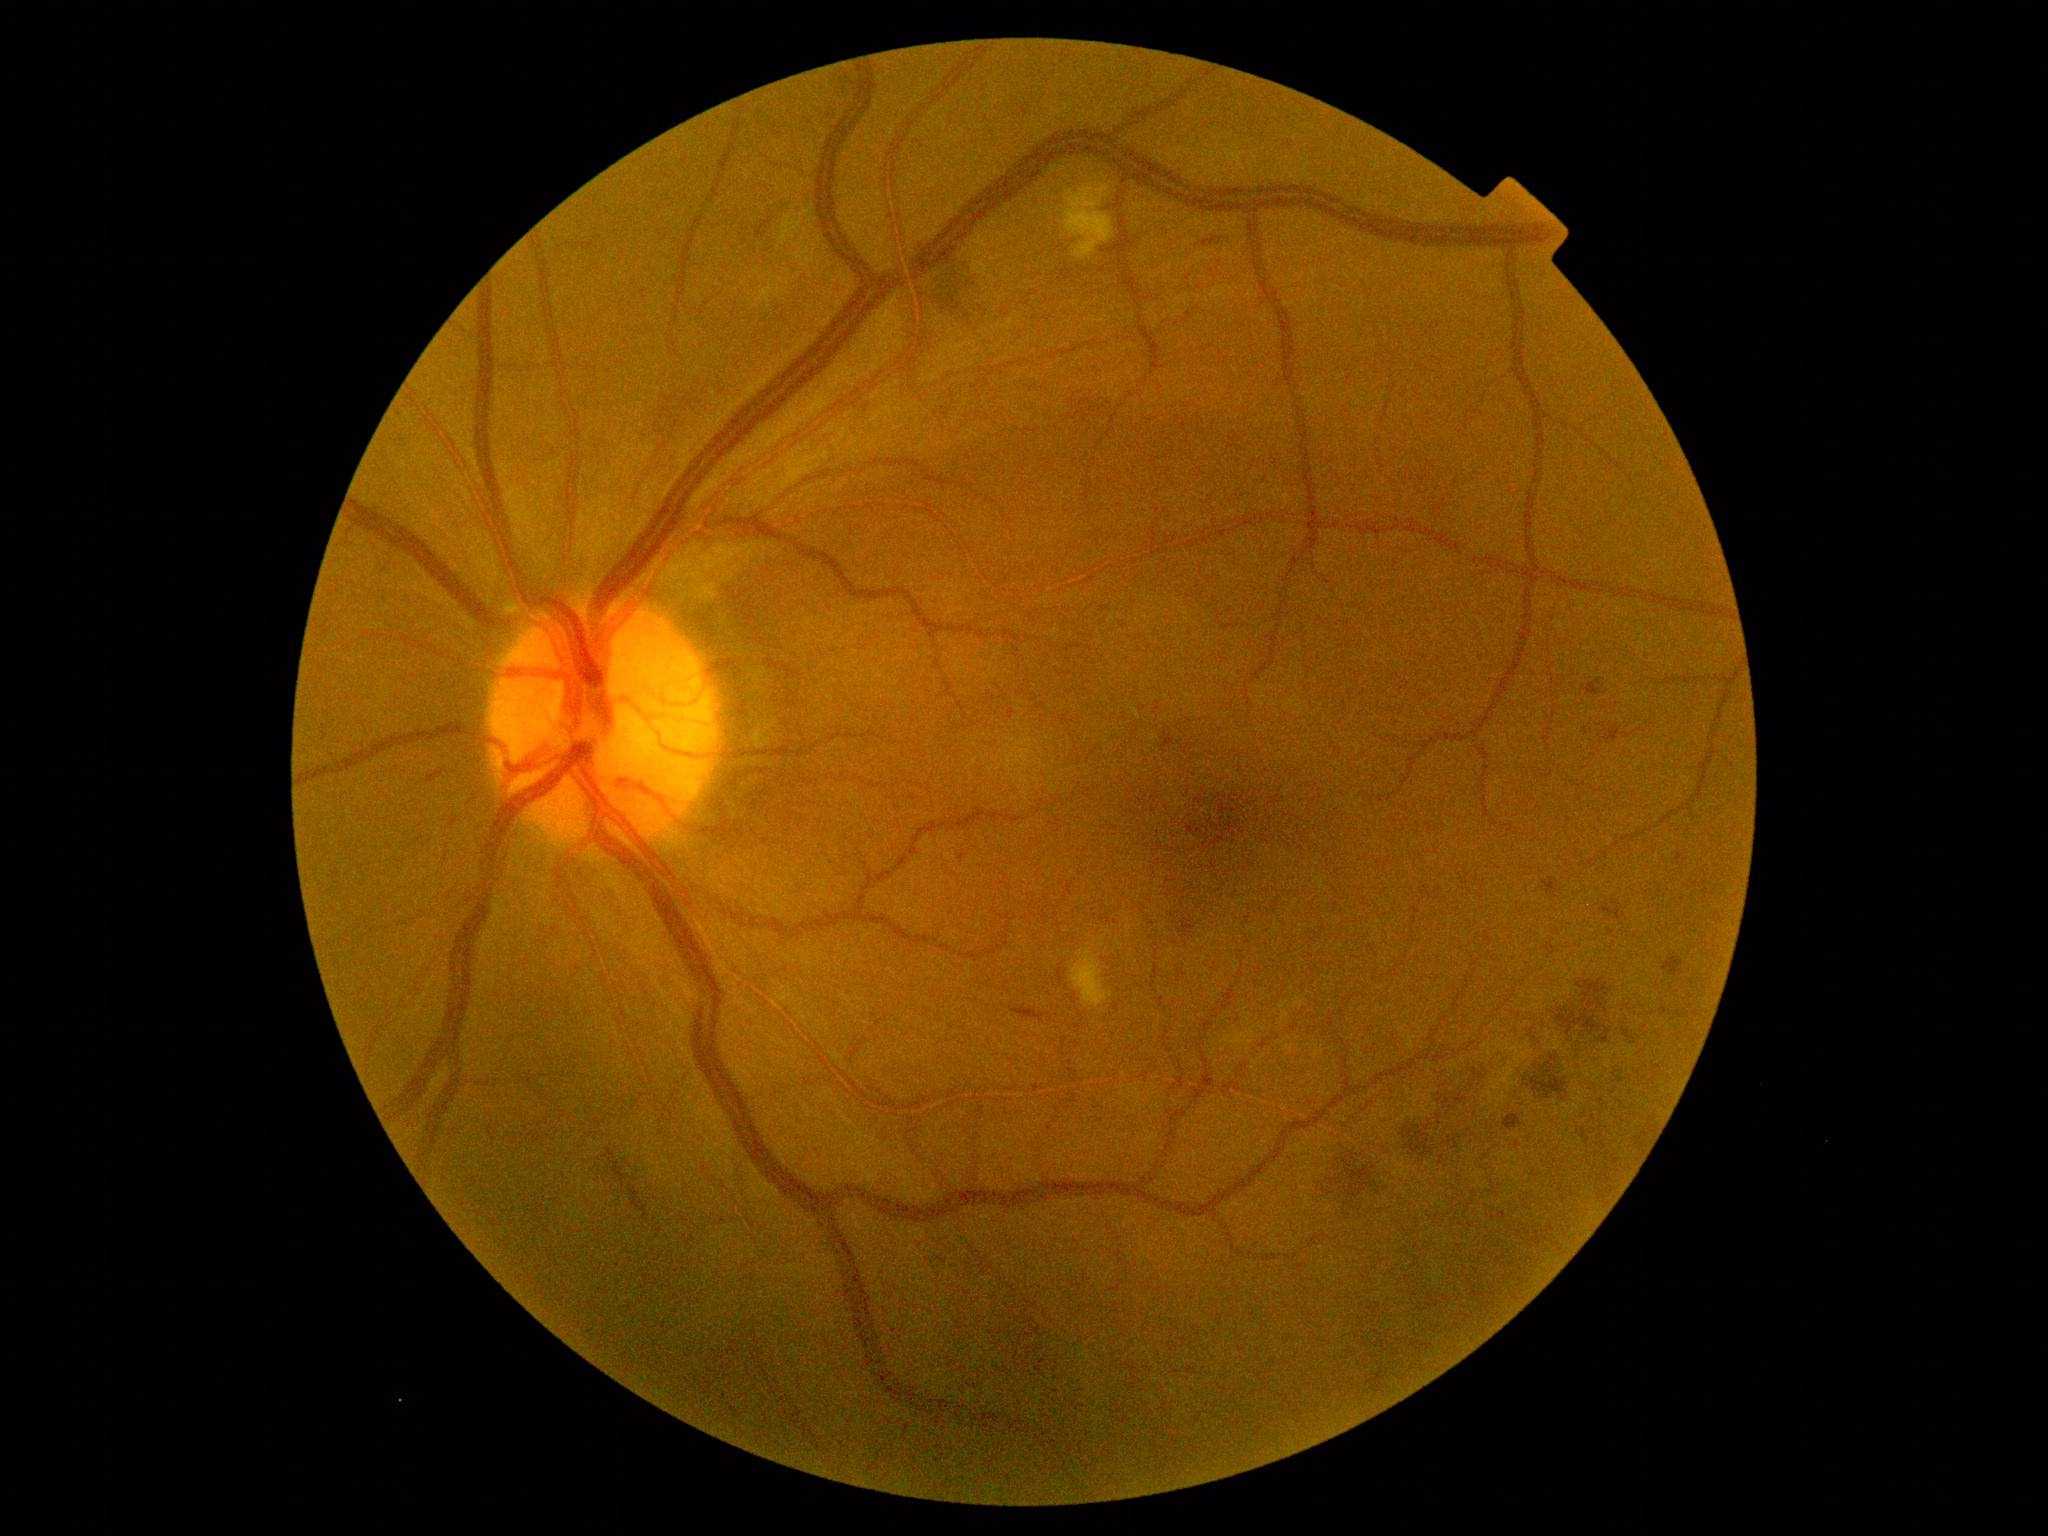

Diabetic retinopathy (DR) is grade 2 (moderate NPDR)
hemorrhages (HEs): (1530,1053,1575,1108), (1203,238,1218,248), (1662,956,1684,977), (605,1148,615,1158), (1013,1006,1047,1023), (754,219,773,239), (1601,725,1645,744), (1558,972,1617,1036), (1503,1115,1523,1131), (1442,1088,1470,1115), (1601,899,1627,920), (1317,1145,1388,1223), (1467,1059,1497,1082), (630,1184,650,1221), (1582,679,1604,697), (1393,1117,1449,1157), (921,251,982,327), (1542,879,1561,899), (609,1160,627,1188)
microaneurysms (MAs): (1483,932,1495,947), (1675,851,1684,867), (1614,1069,1624,1084), (938,1257,947,1264), (1532,1028,1545,1049), (424,772,437,783), (828,114,835,123), (1179,919,1195,937), (1581,1128,1591,1145), (1160,732,1175,754), (1622,1029,1635,1042), (960,853,967,861)
Small MAs near [x=1266, y=479], [x=1615, y=1082]
hard exudates (EXs): not present
soft exudates (SEs): (1071,944,1113,1008), (1060,179,1114,261)